45-degree field of view · fundus photo: 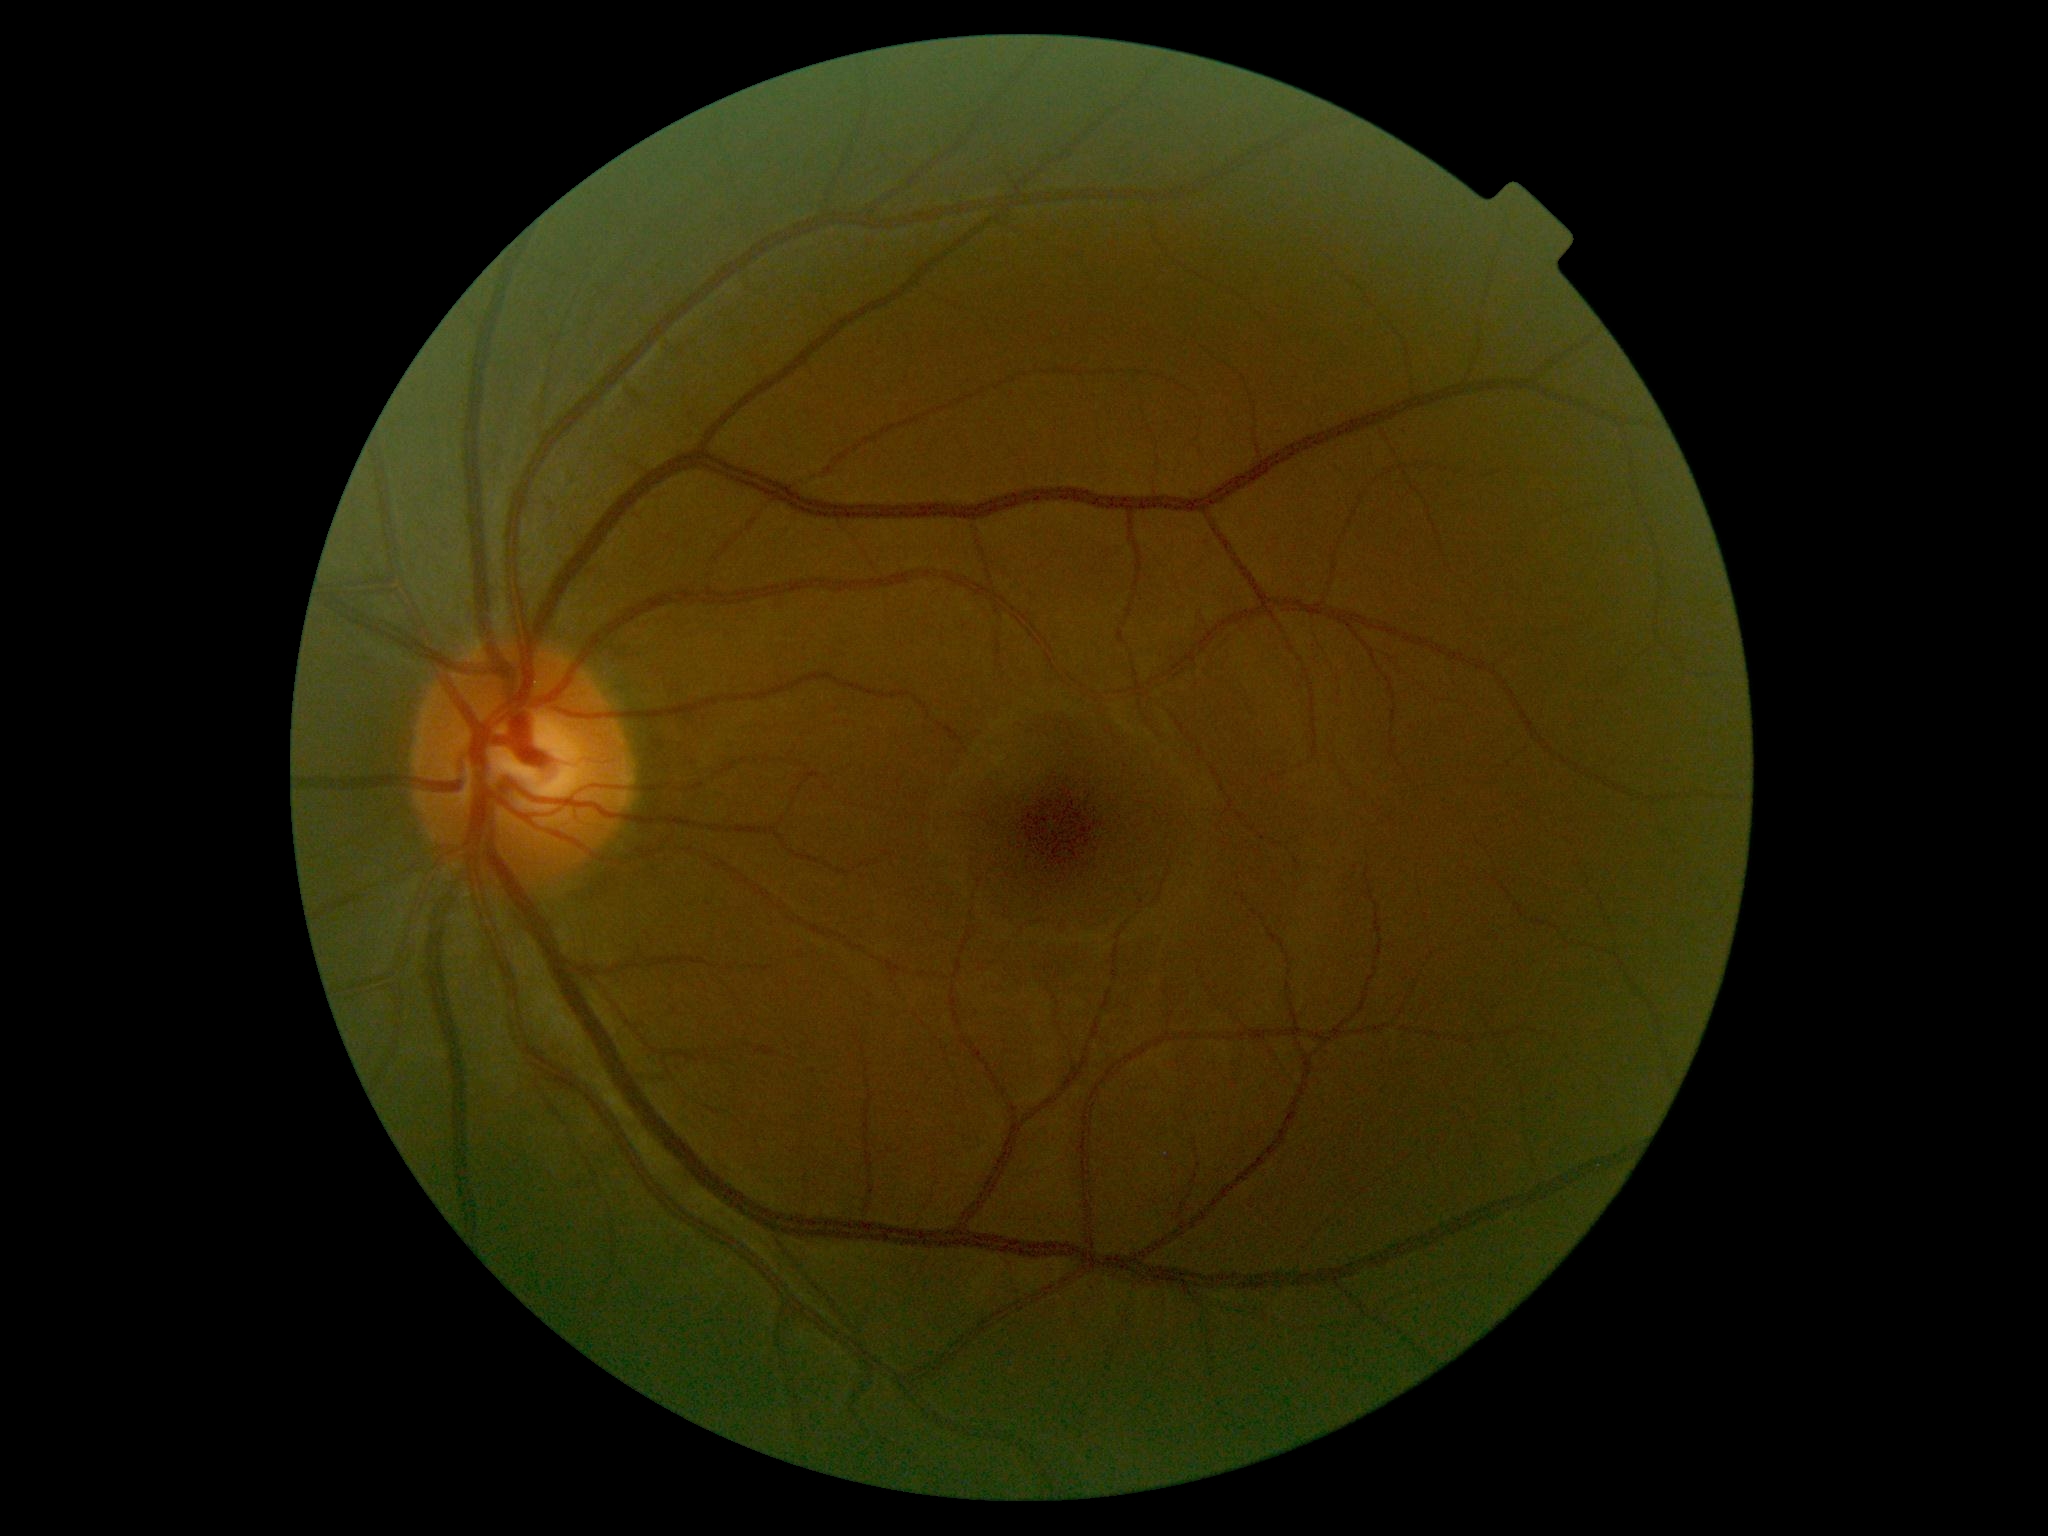

DR impression = no apparent DR, diabetic retinopathy (DR) = grade 0.